Retinal fundus photograph; FOV: 45 degrees; image size 2346x1568.
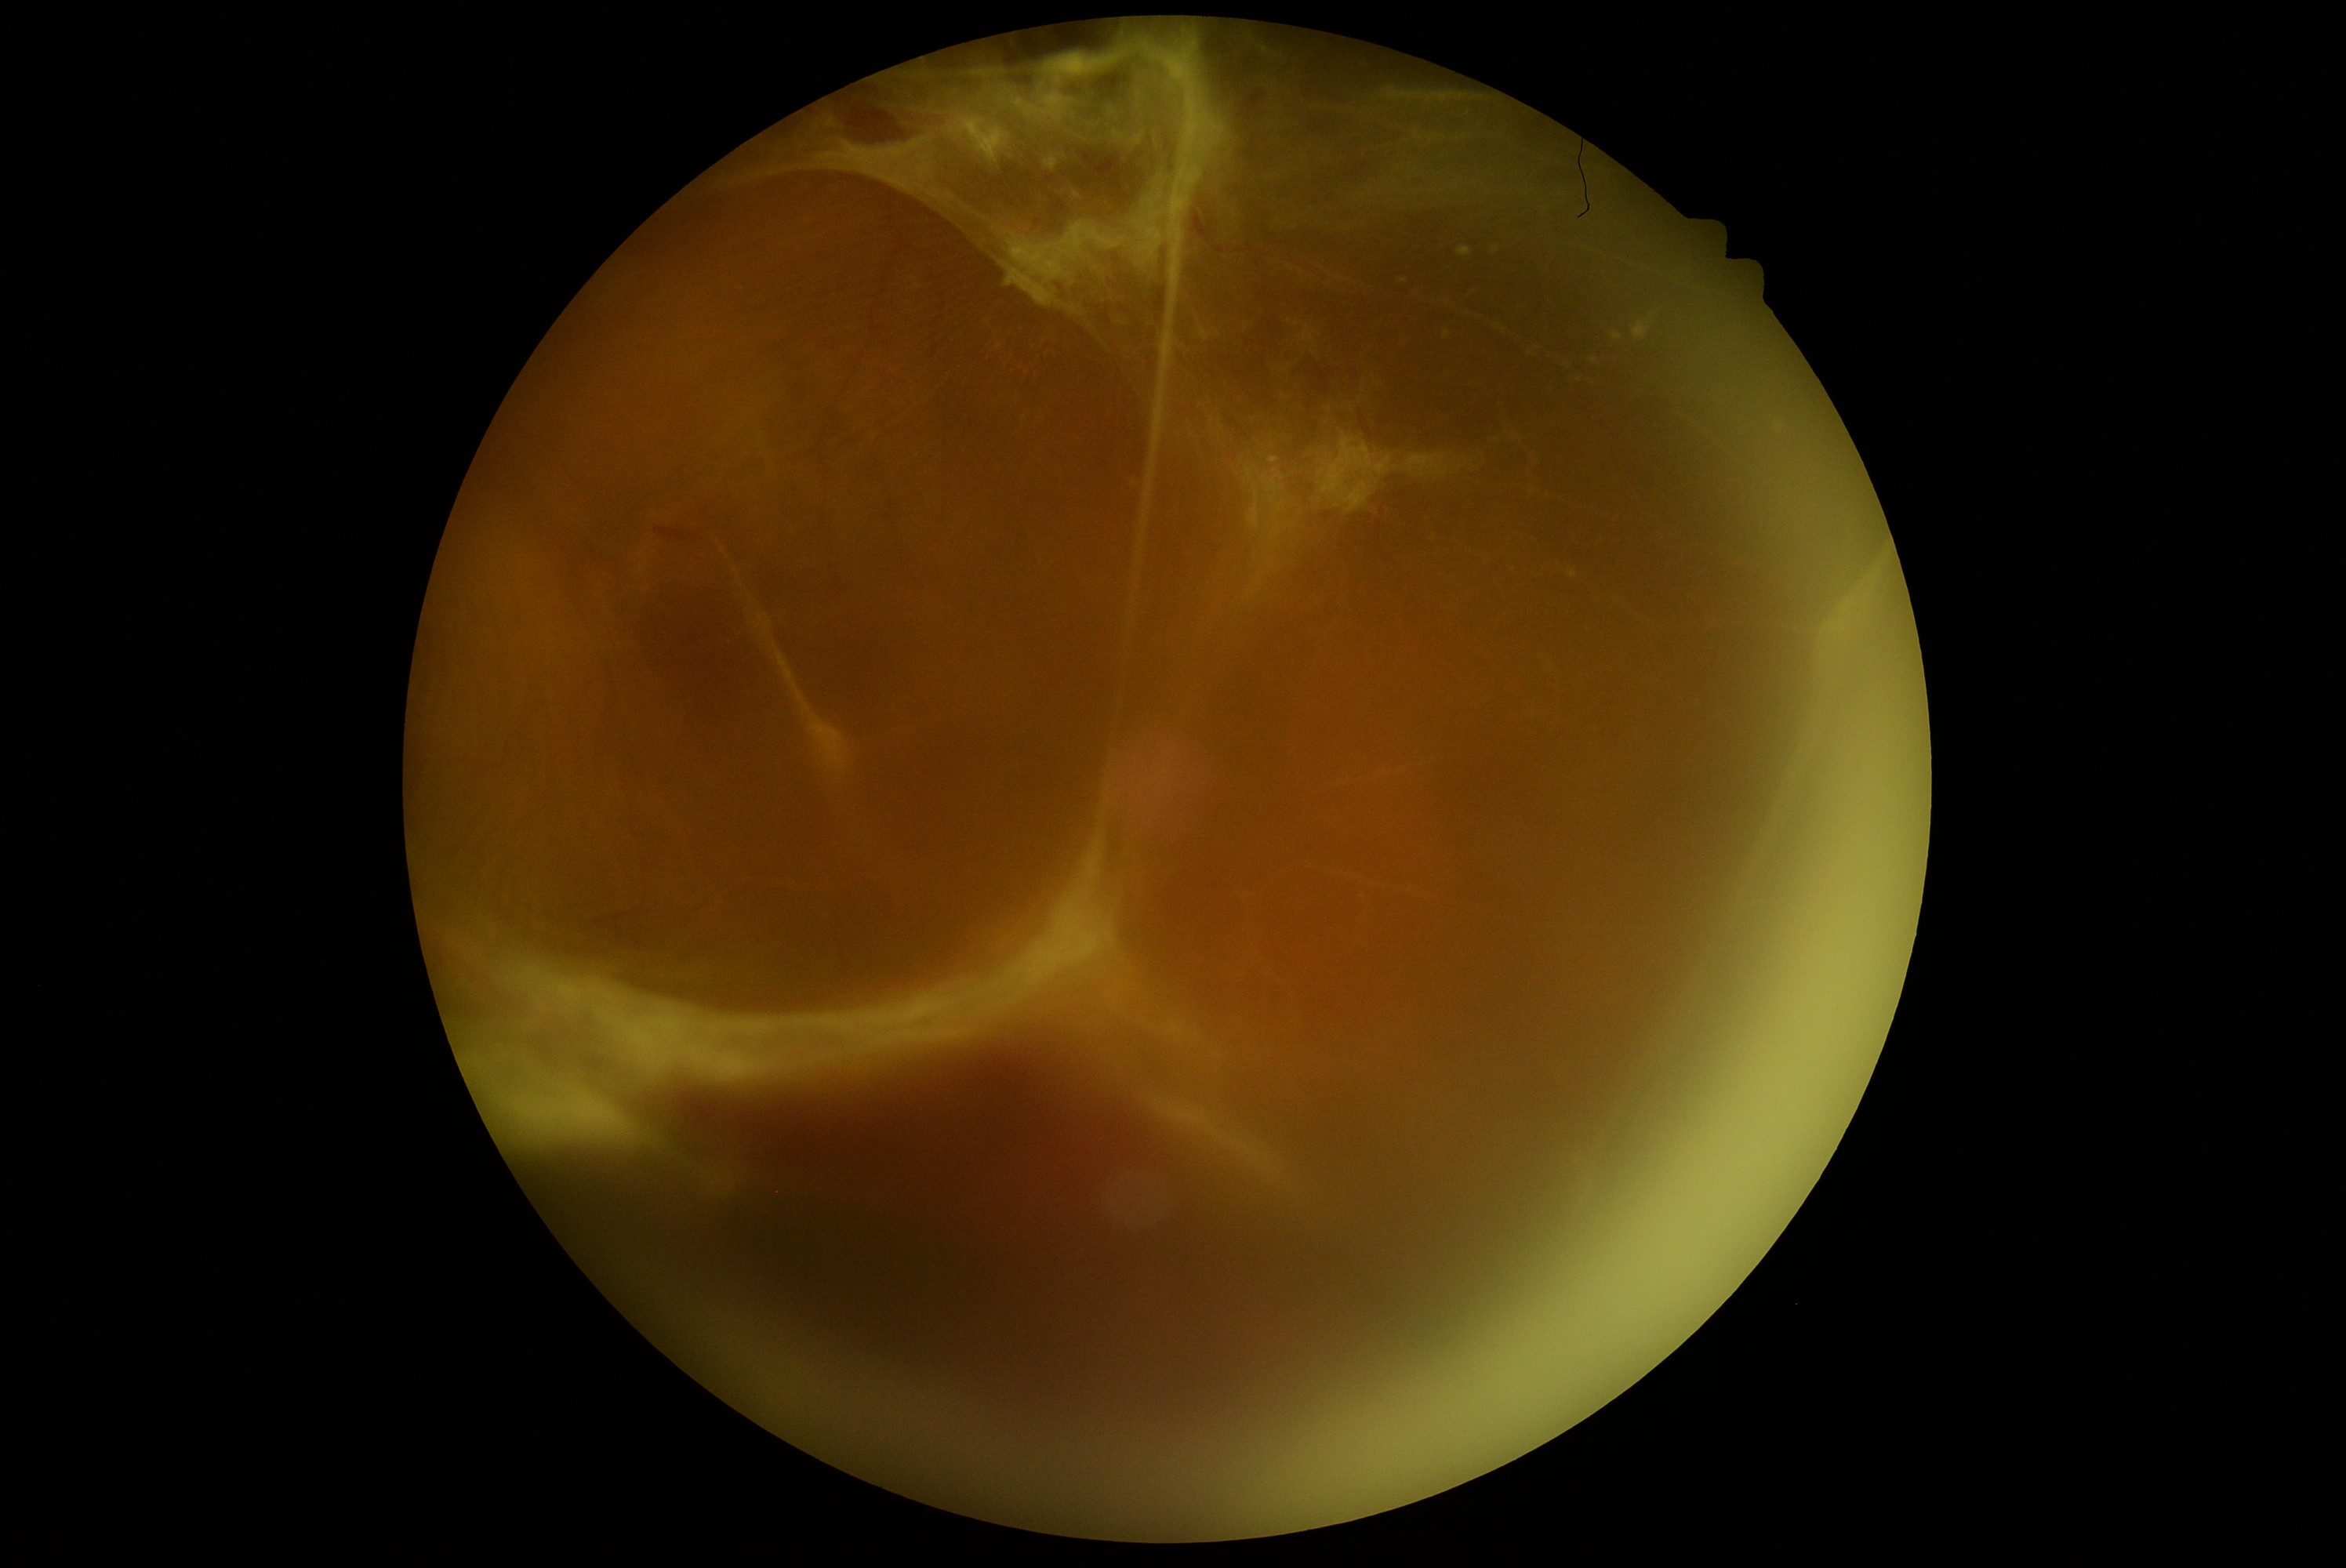

{
  "dr_grade": "4/4"
}